Wide-field contact fundus photograph of an infant · 640x480px:
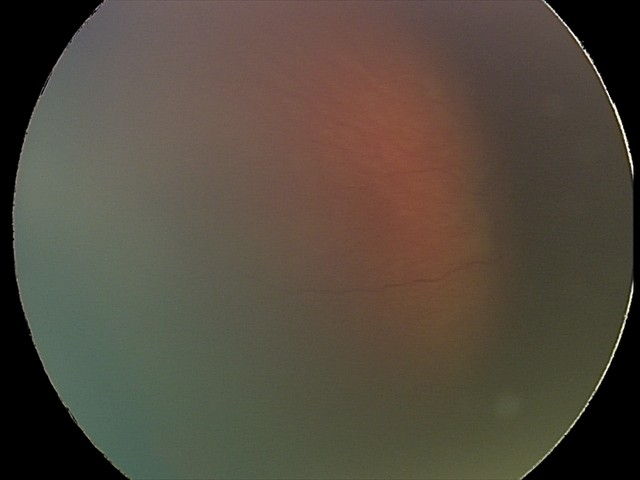

Series diagnosed as retinal hemorrhages.